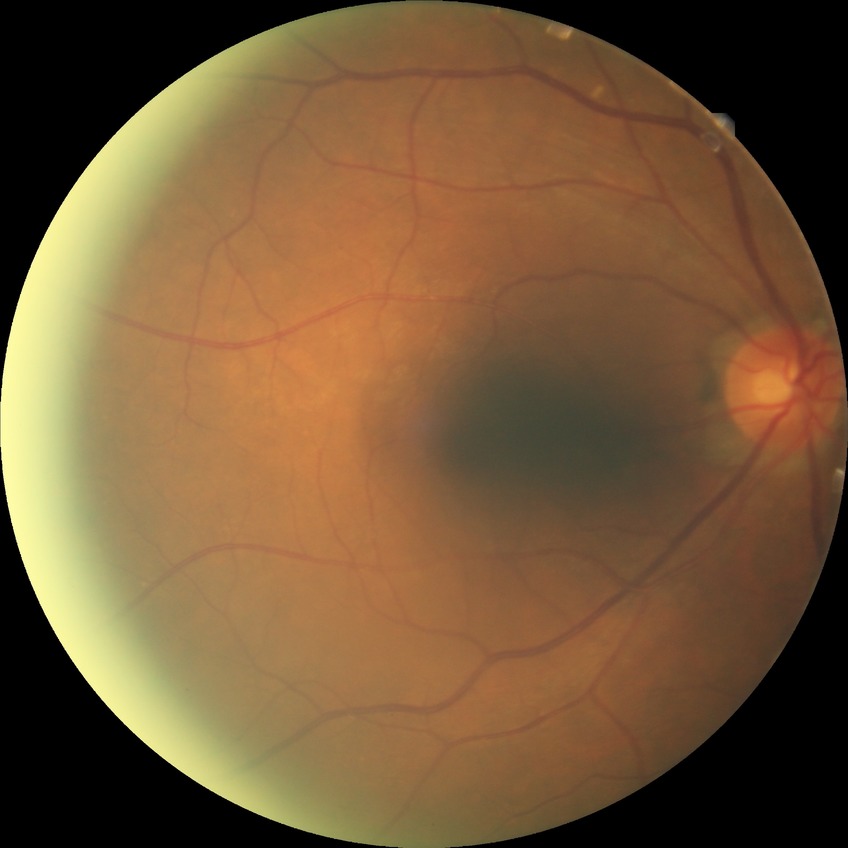
Diabetic retinopathy (DR): no diabetic retinopathy (NDR).